Nonmydriatic fundus photograph, 45° FOV.
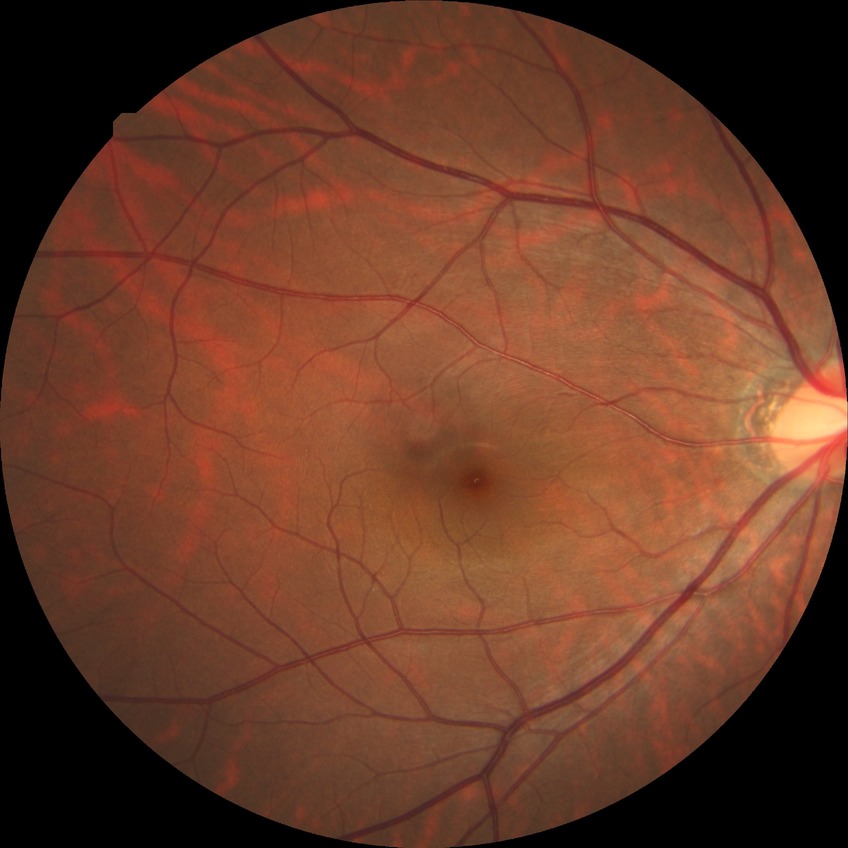 Modified Davis grading is no diabetic retinopathy.